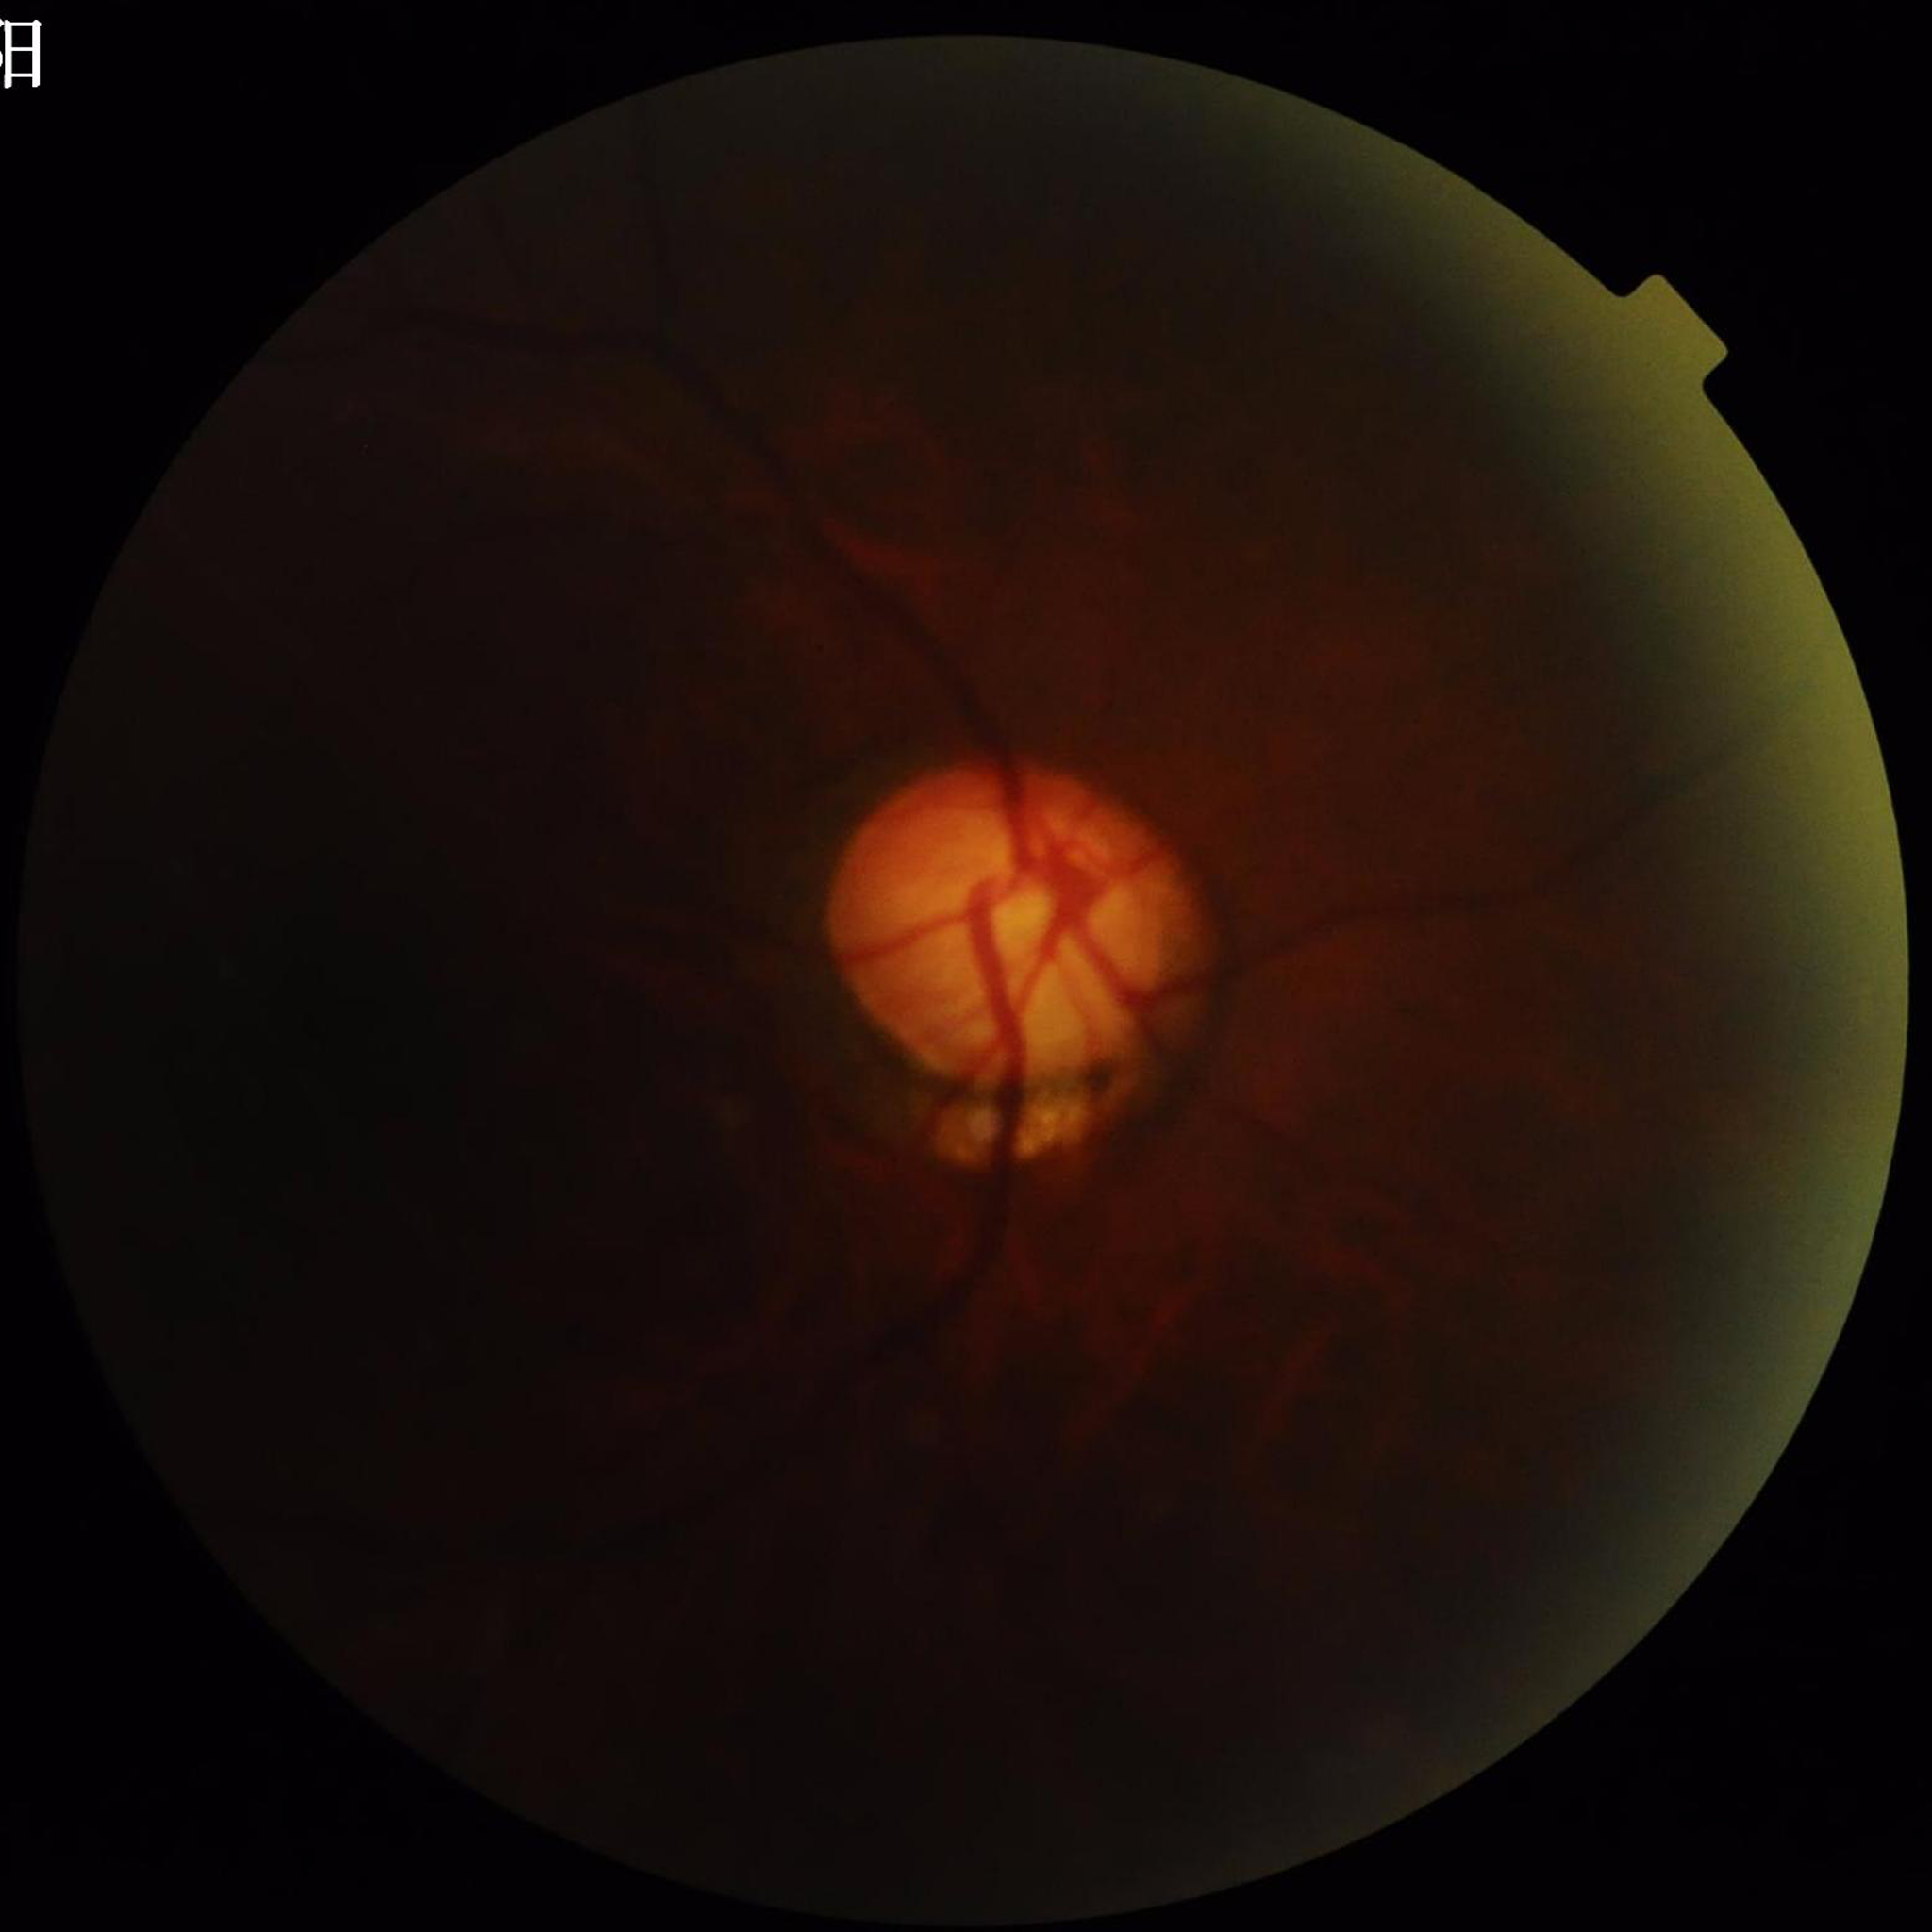 Quality = illumination/color distortion present, blur present, low contrast | Disease = glaucoma.